DR severity per modified Davis staging
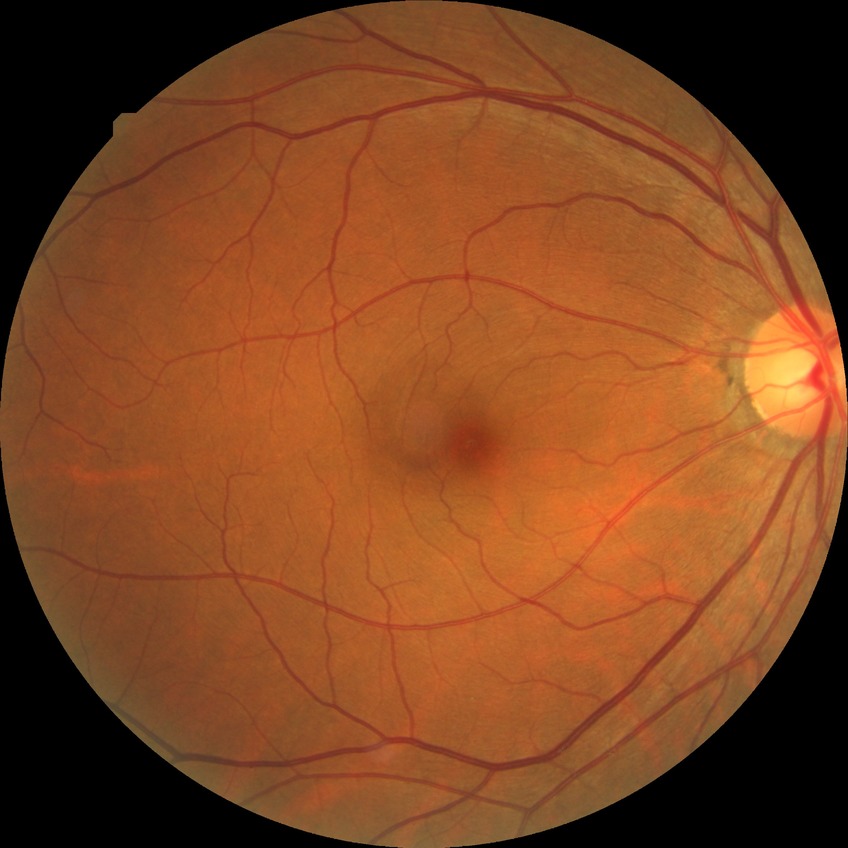

DR severity is NDR.